NIDEK AFC-230. DR severity per modified Davis staging: 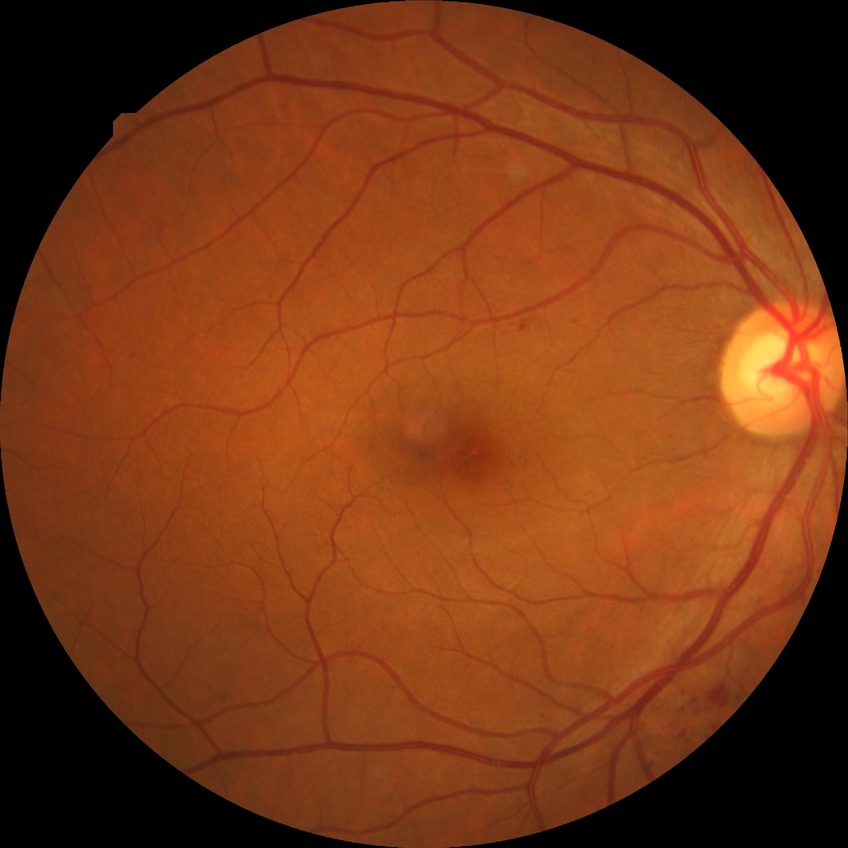 retinopathy stage: simple diabetic retinopathy.